Pediatric retinal photograph (wide-field); 1240 by 1240 pixels:
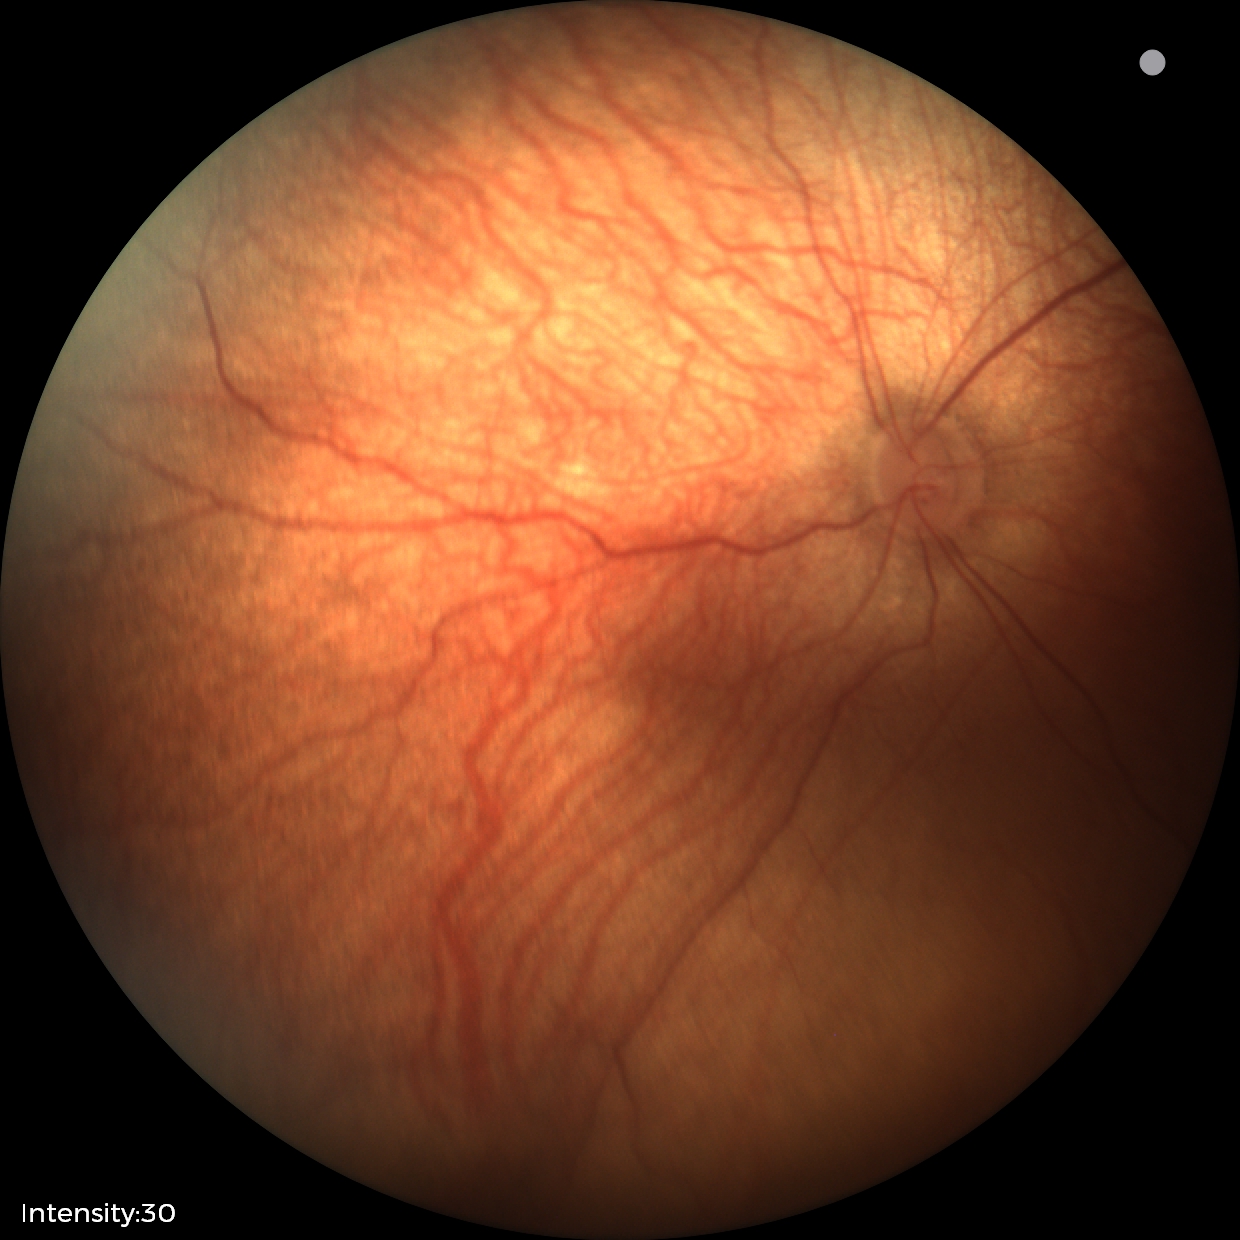 Assessment = physiological.